848 by 848 pixels; Davis DR grading; 45° FOV.
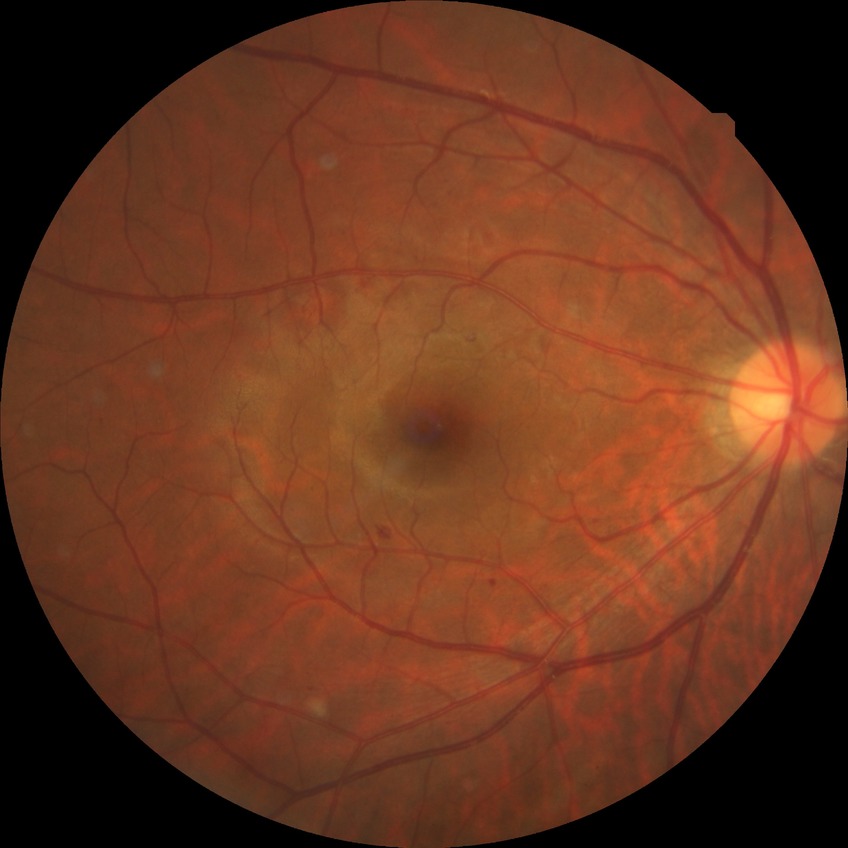   davis_grade: simple diabetic retinopathy